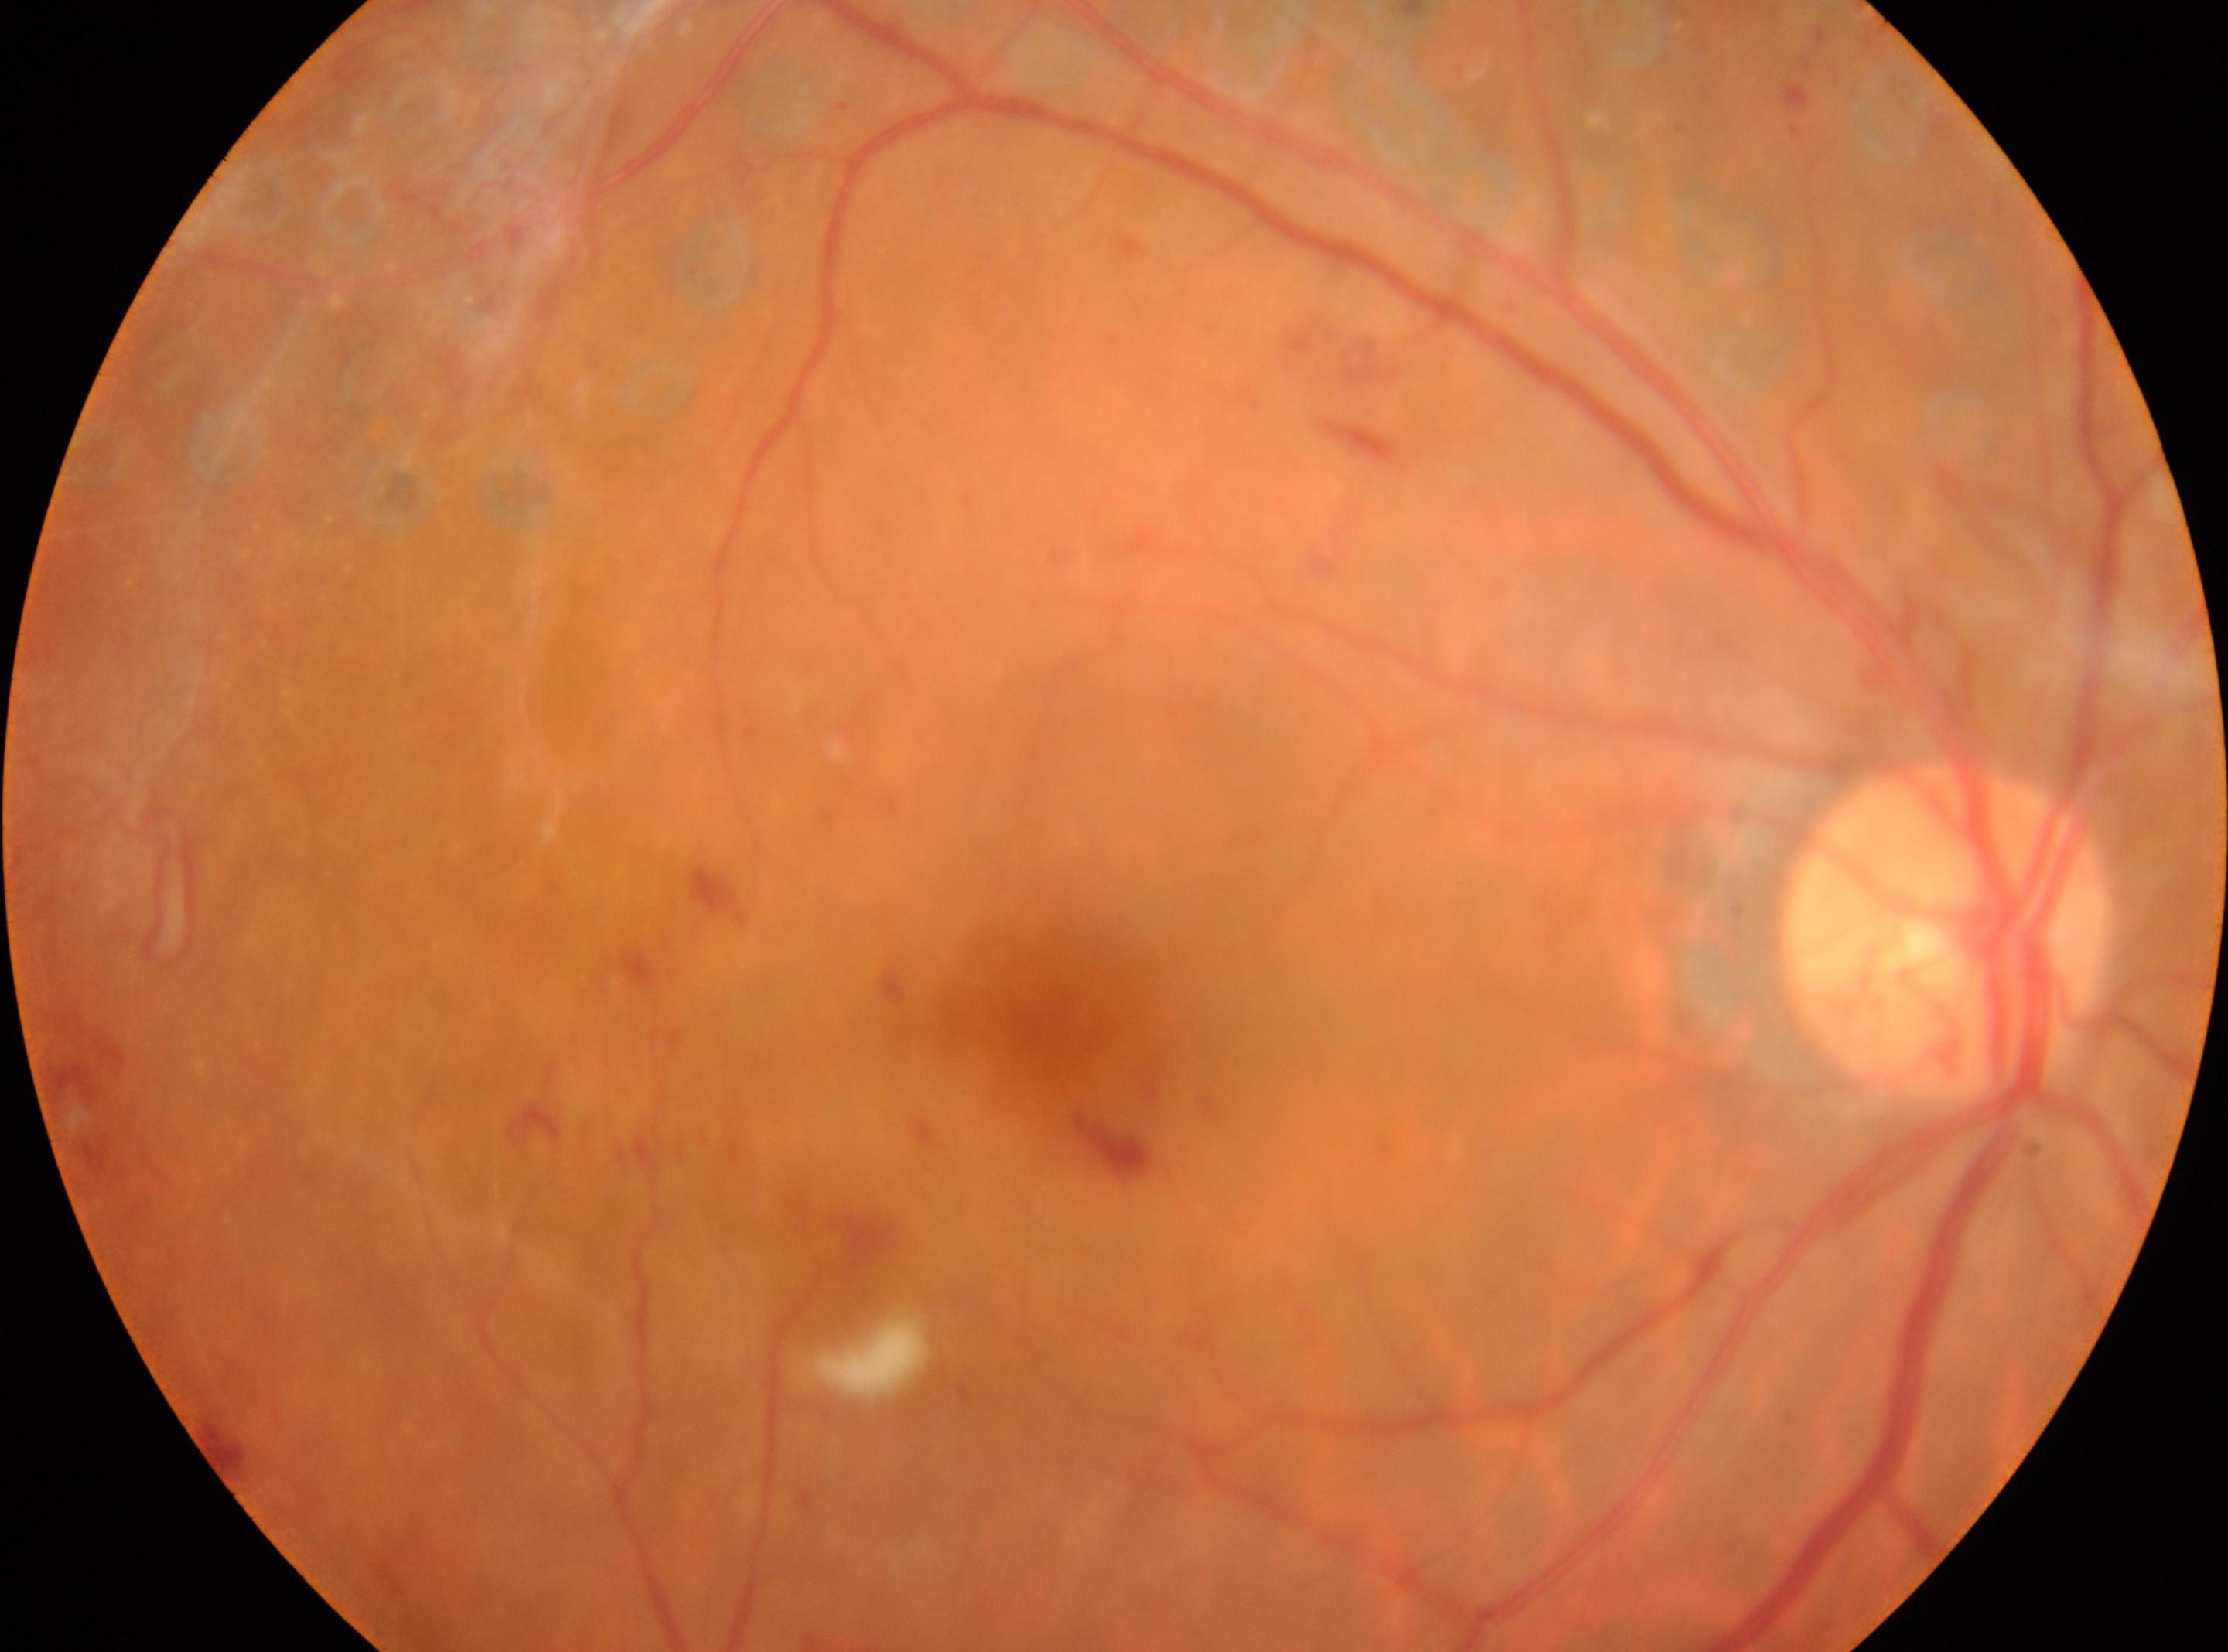 DR stage is DR with laser photocoagulation scars.
The fovea centralis is at (x: 1046, y: 1015).
The optic disc center is at (x: 1945, y: 934).
Imaged eye: OD.